2184x1690.
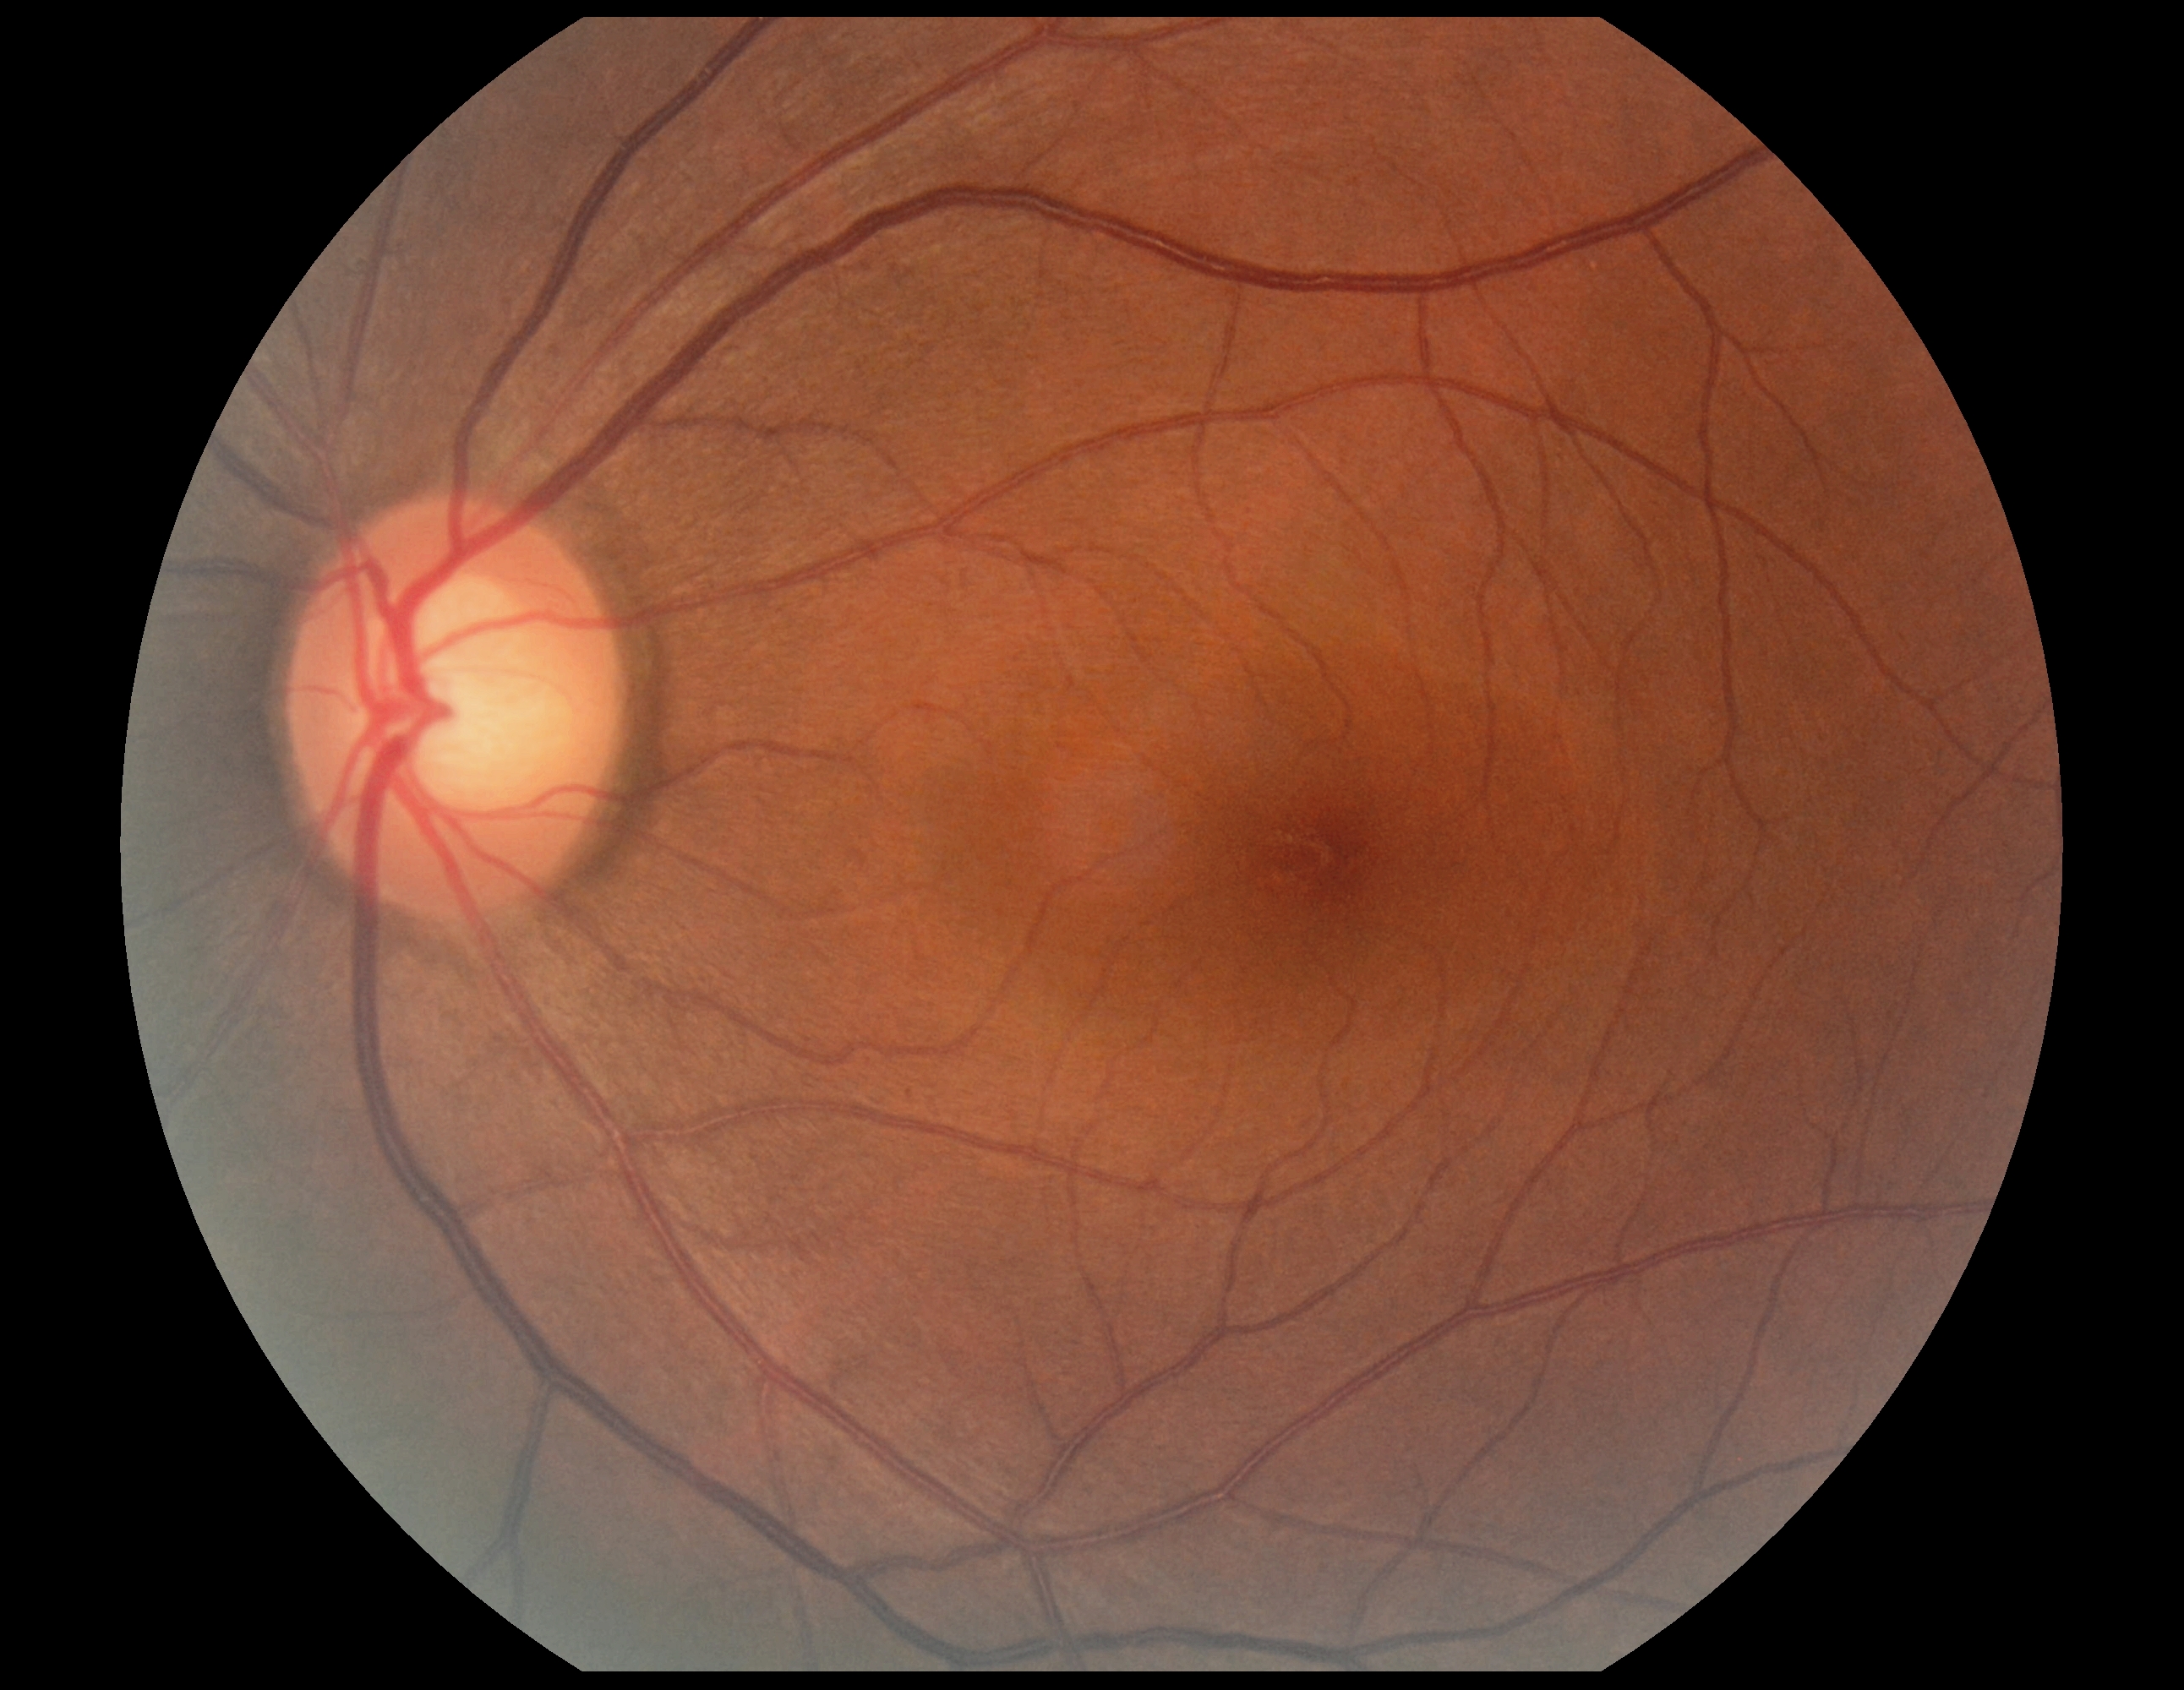
dr_grade: no apparent retinopathy (grade 0) — no visible signs of diabetic retinopathy